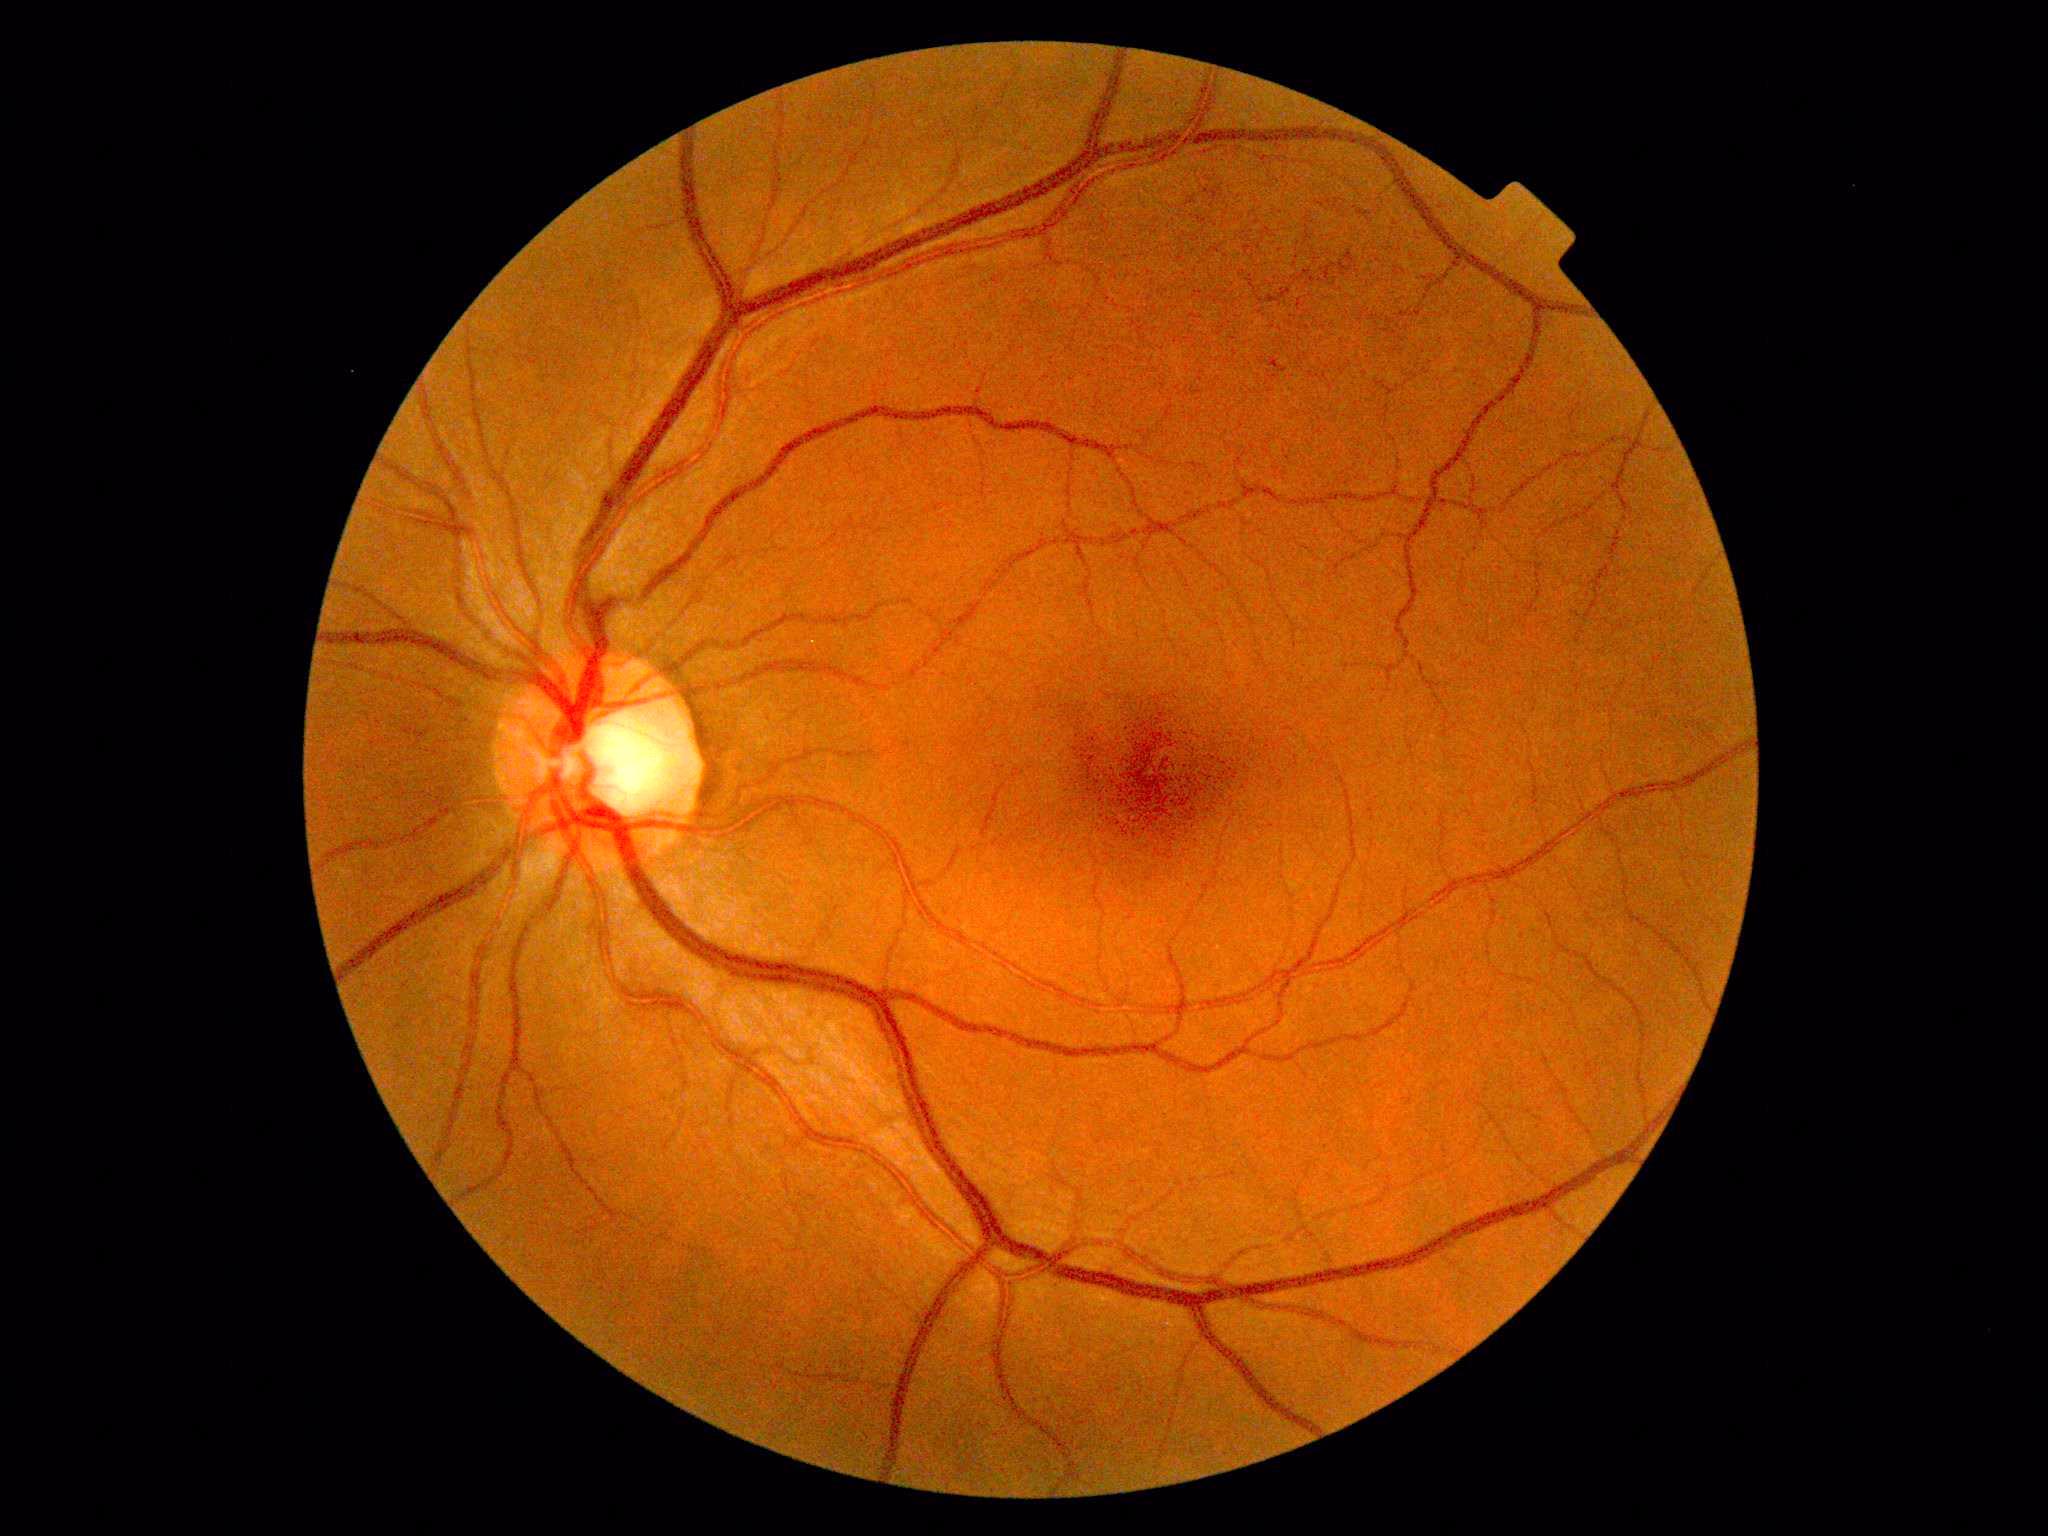
DR stage is grade 1 — presence of microaneurysms only. DR class: non-proliferative diabetic retinopathy.